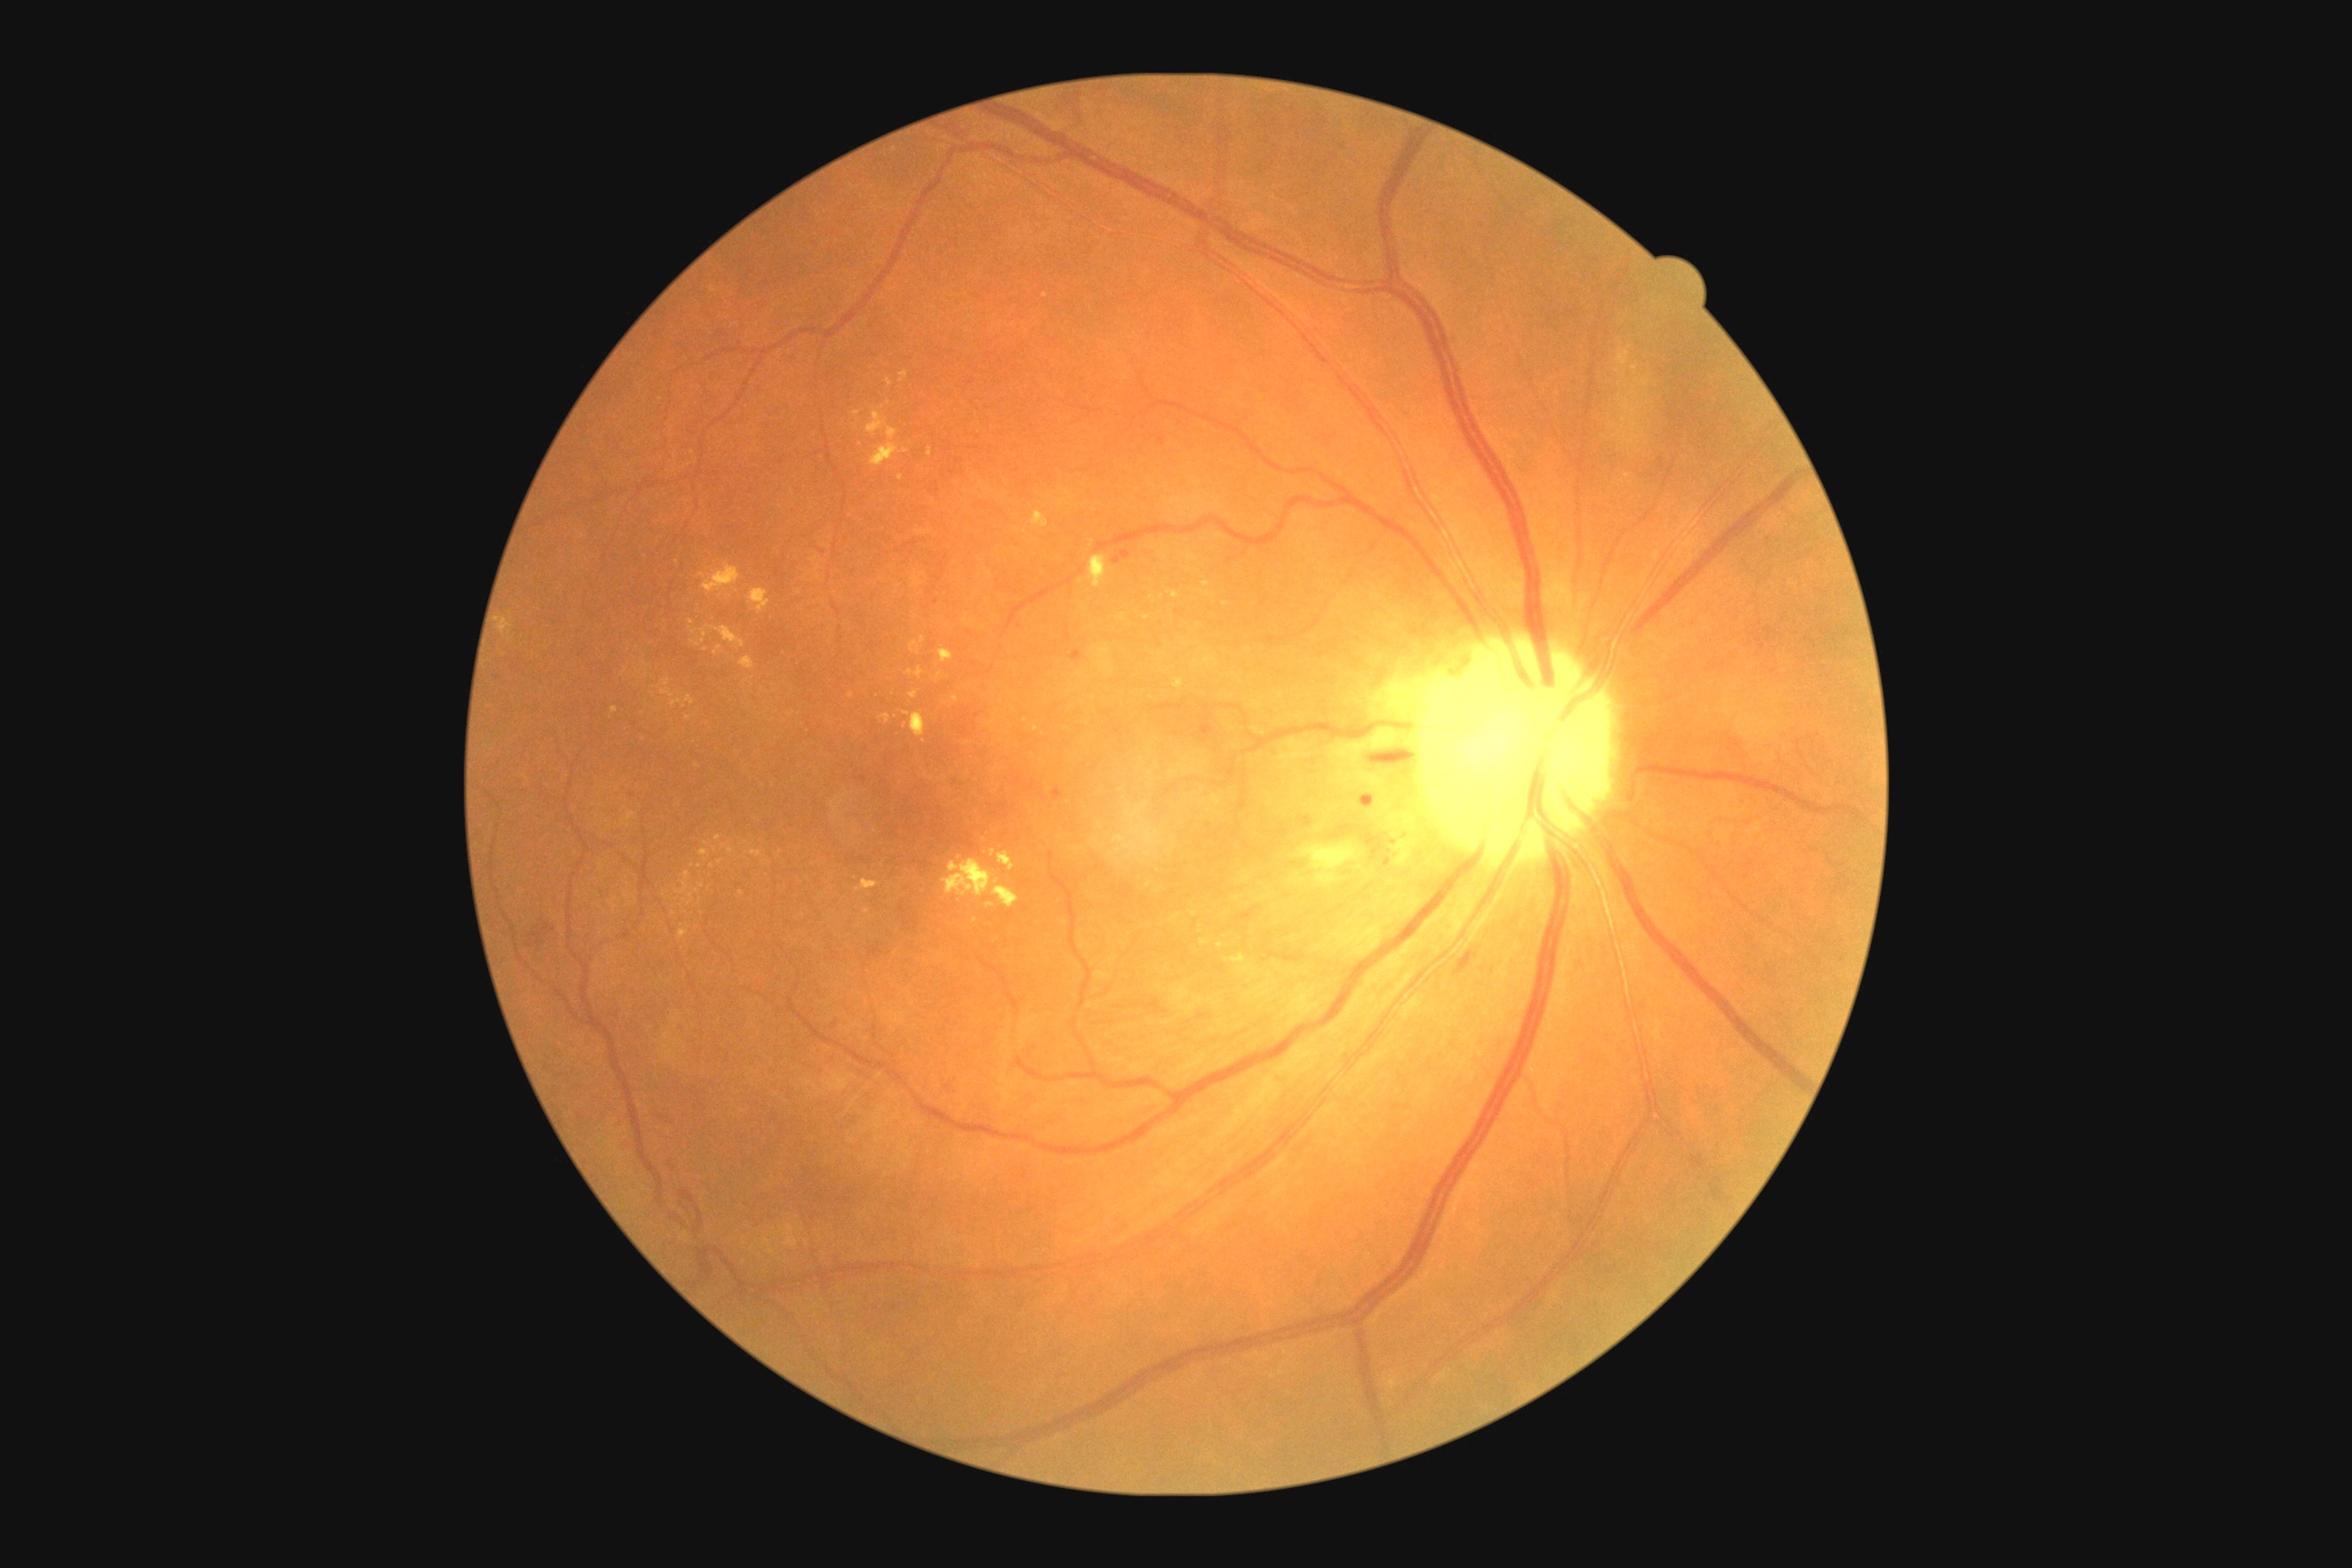

partial: true
dr_grade: 2
dr_grade_name: moderate NPDR
lesions:
  ex:
    - (750,850,761,858)
    - (899,371,908,384)
    - (660,680,674,698)
    - (867,406,899,442)
    - (749,591,770,614)
    - (1242,966,1251,974)
    - (990,848,995,858)
    - (1226,954,1246,963)
    - (685,696,696,705)
  ex_small_centers:
    - 857/414
    - 1036/729
    - 730/851
    - 716/850
    - 702/886
    - 1026/721
    - 647/674
    - 674/914
    - 688/718
    - 1194/914